FOV: 45 degrees; camera: NIDEK AFC-230.
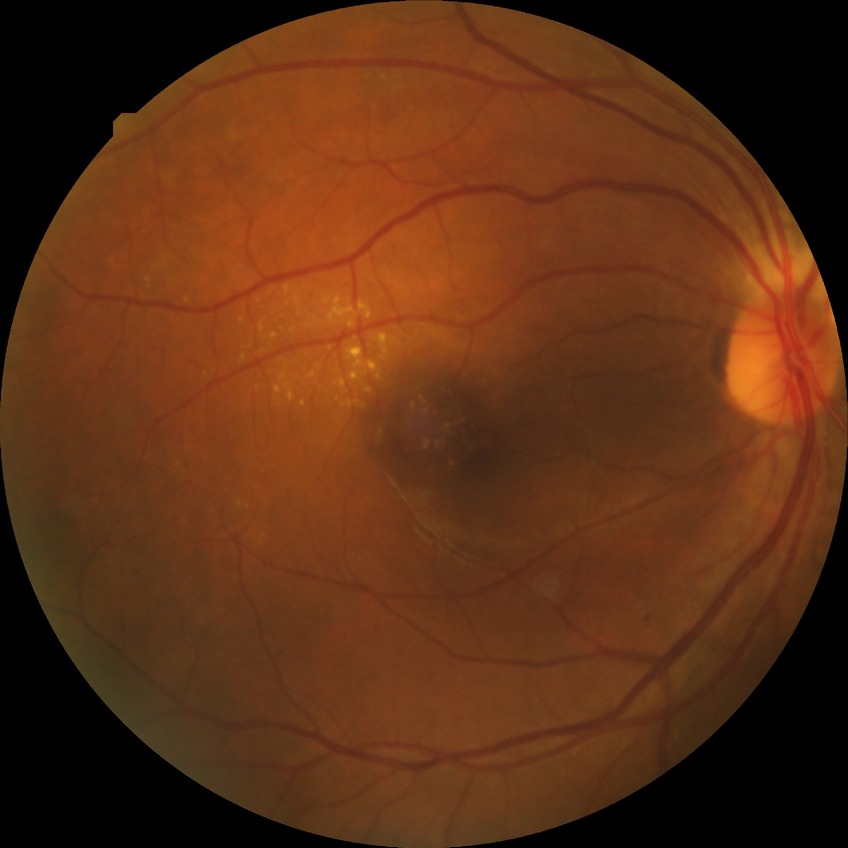 Davis DR grade: SDR.